Handheld portable fundus camera image:
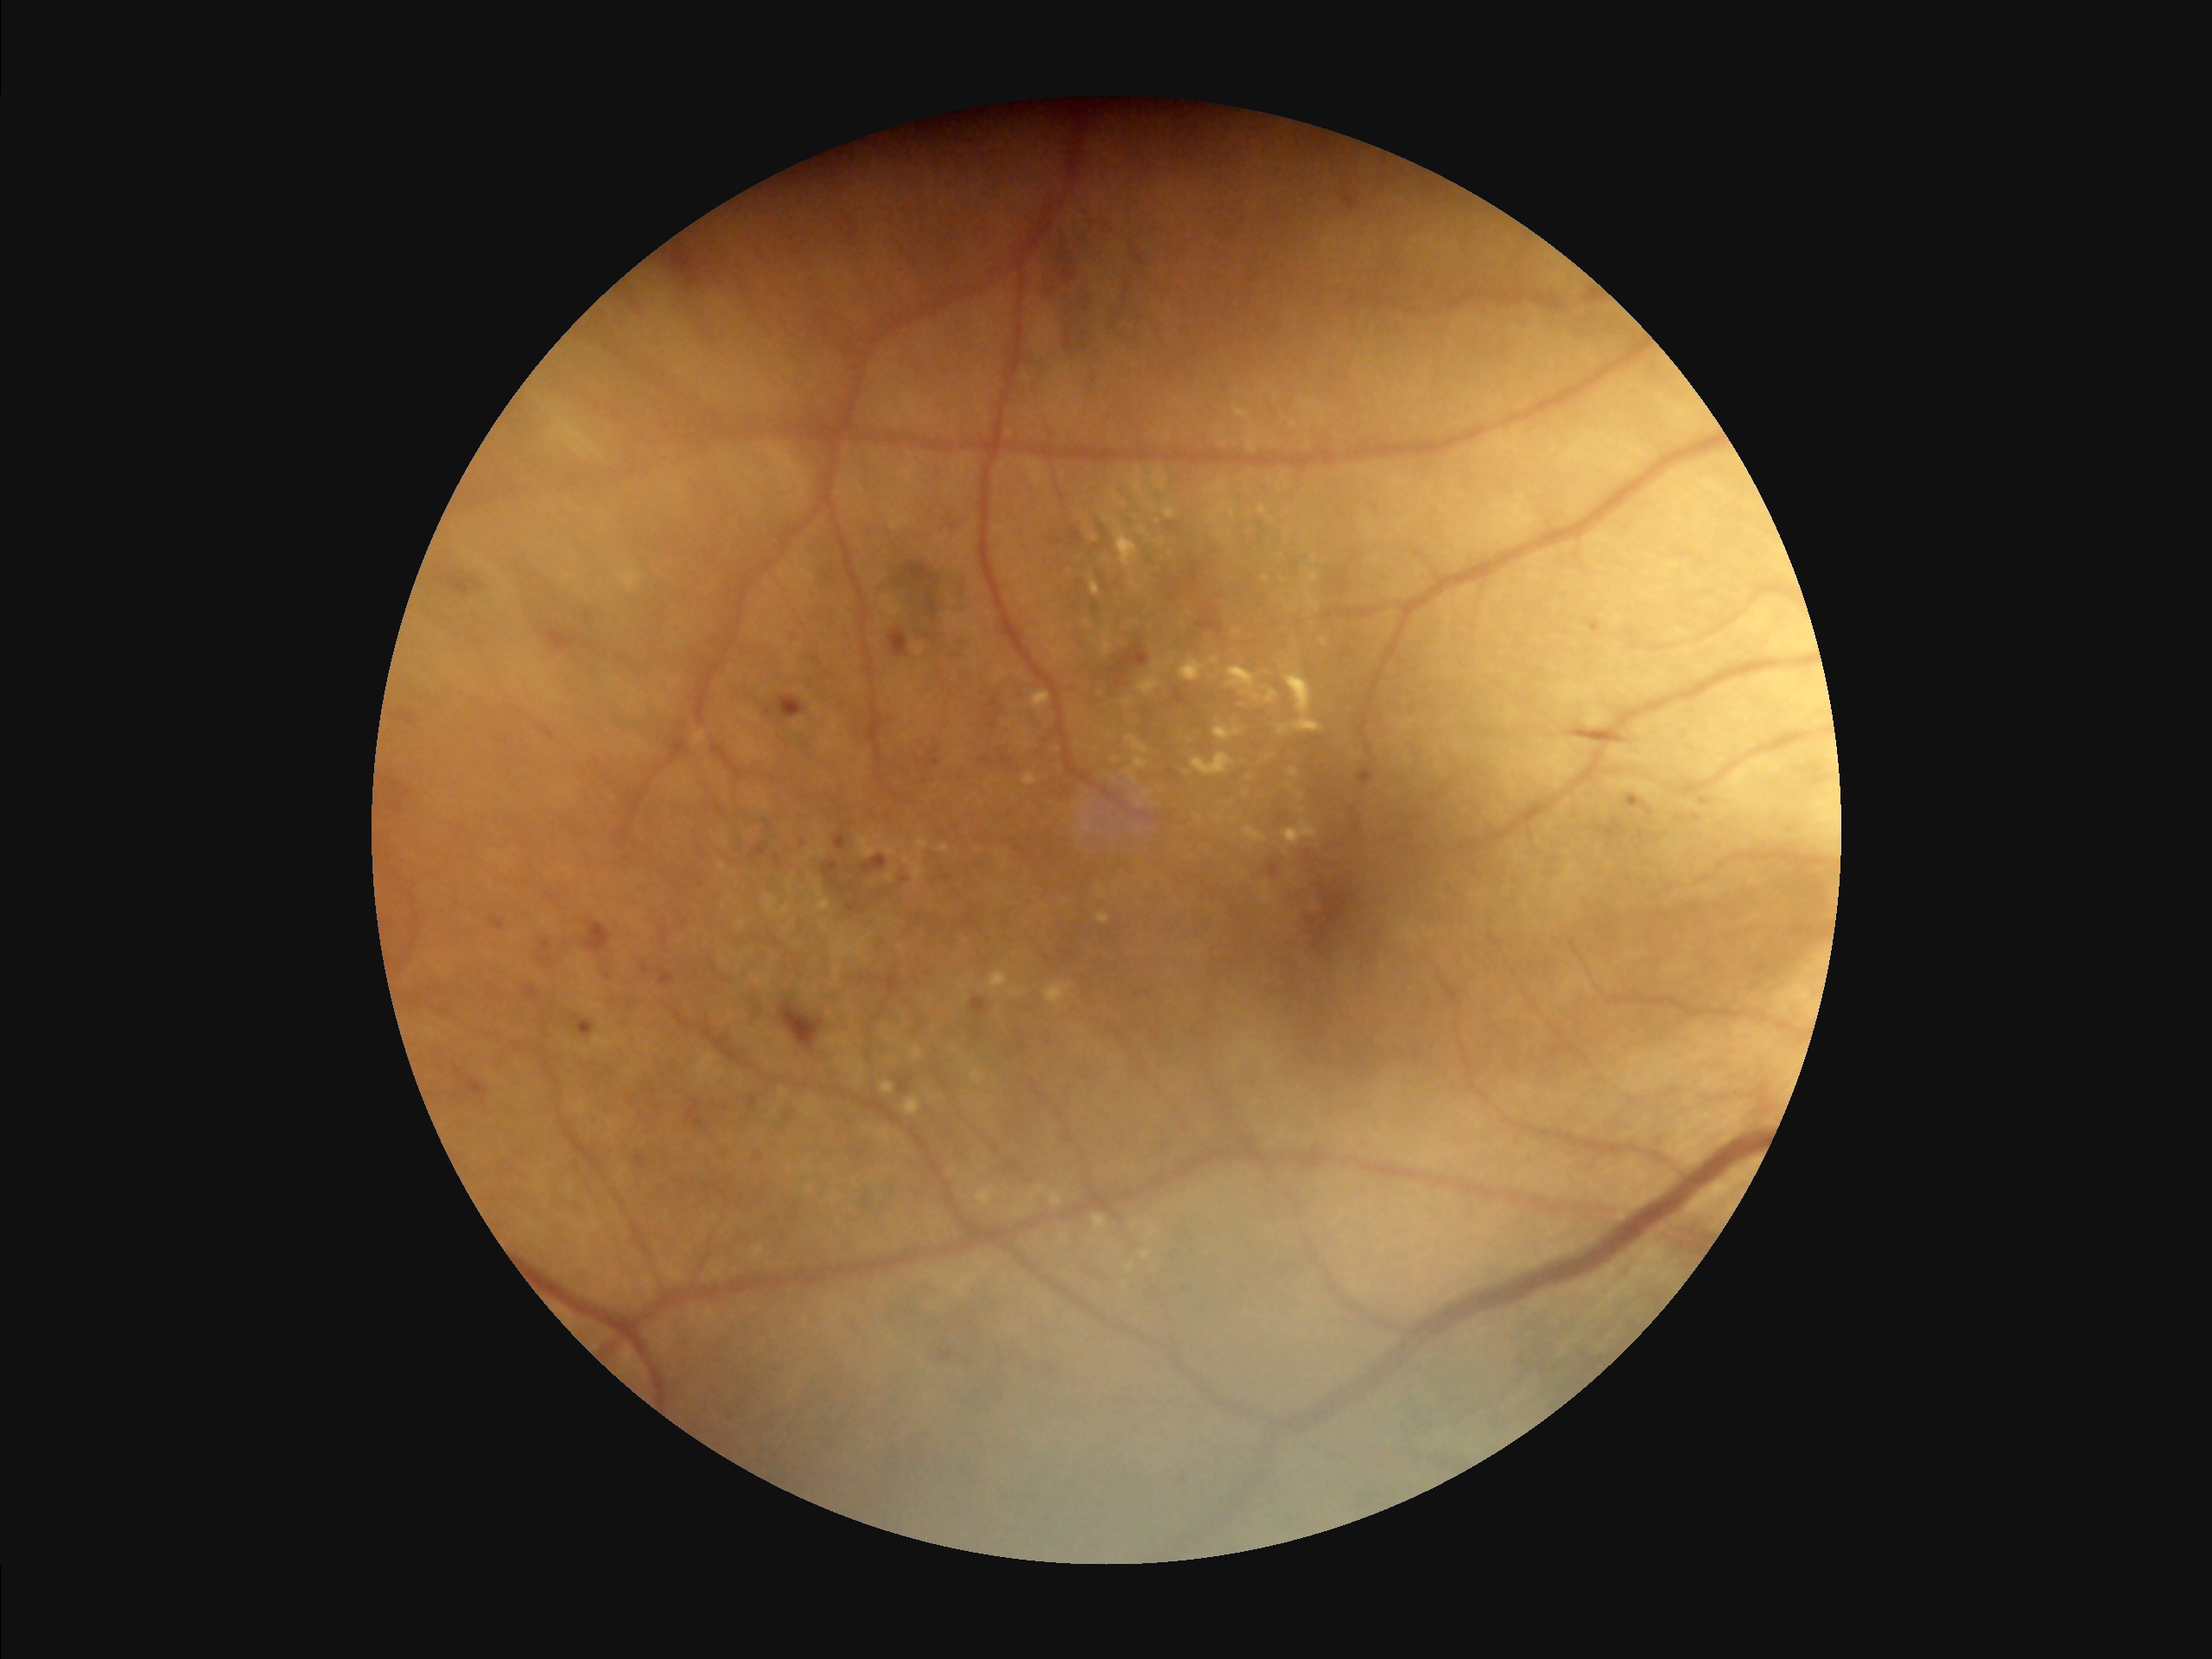
Overall quality is poor; the image is difficult to grade. Contrast is good. Noticeable blur in the optic disc, vessels, or background.